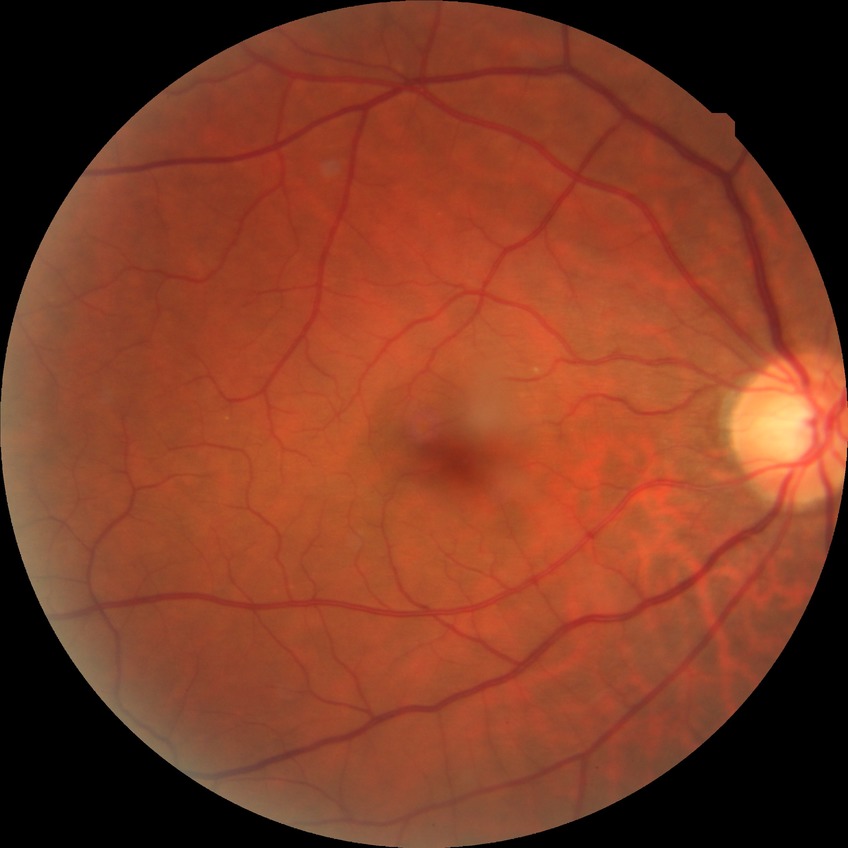
diabetic retinopathy (DR): no diabetic retinopathy (NDR).